Without pupil dilation.
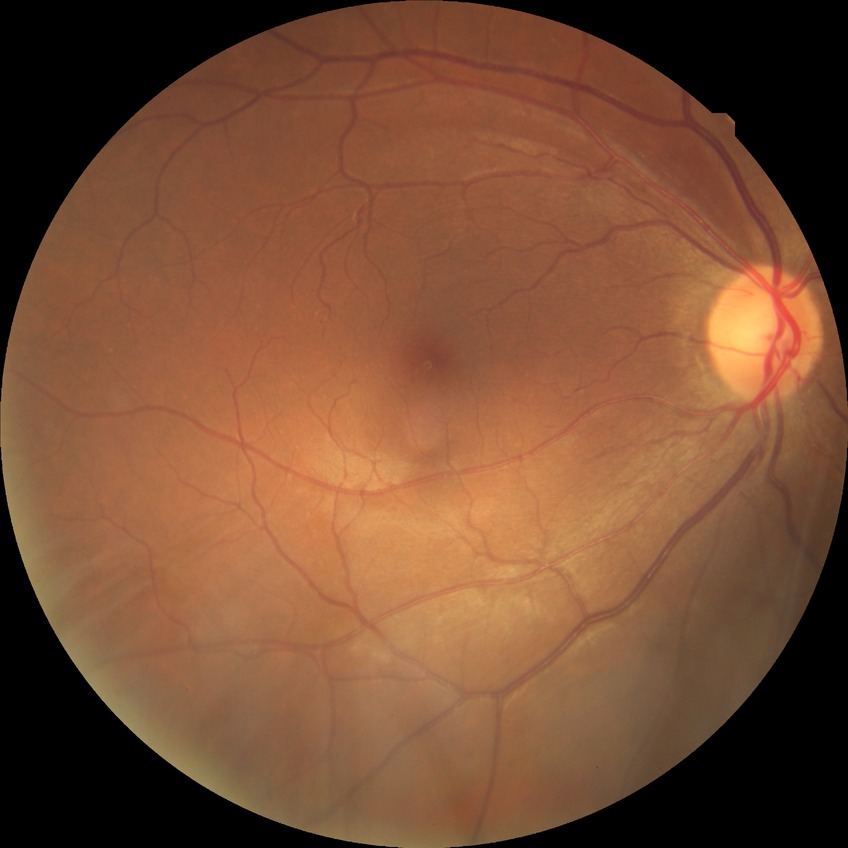
davis_grade: NDR
dr_impression: no DR findings